640x480px. Pediatric wide-field fundus photograph: 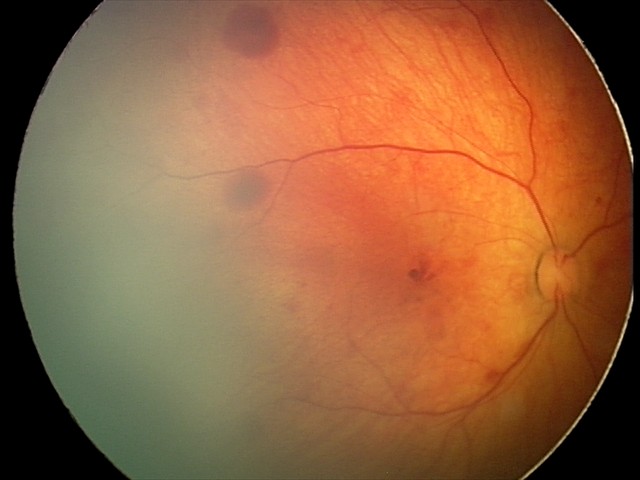 Screening examination consistent with retinal hemorrhages.